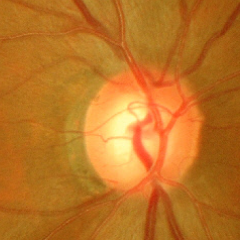
Glaucomatous optic neuropathy is present. Assessment: severe glaucomatous damage.